45-degree field of view · 2346 by 1568 pixels
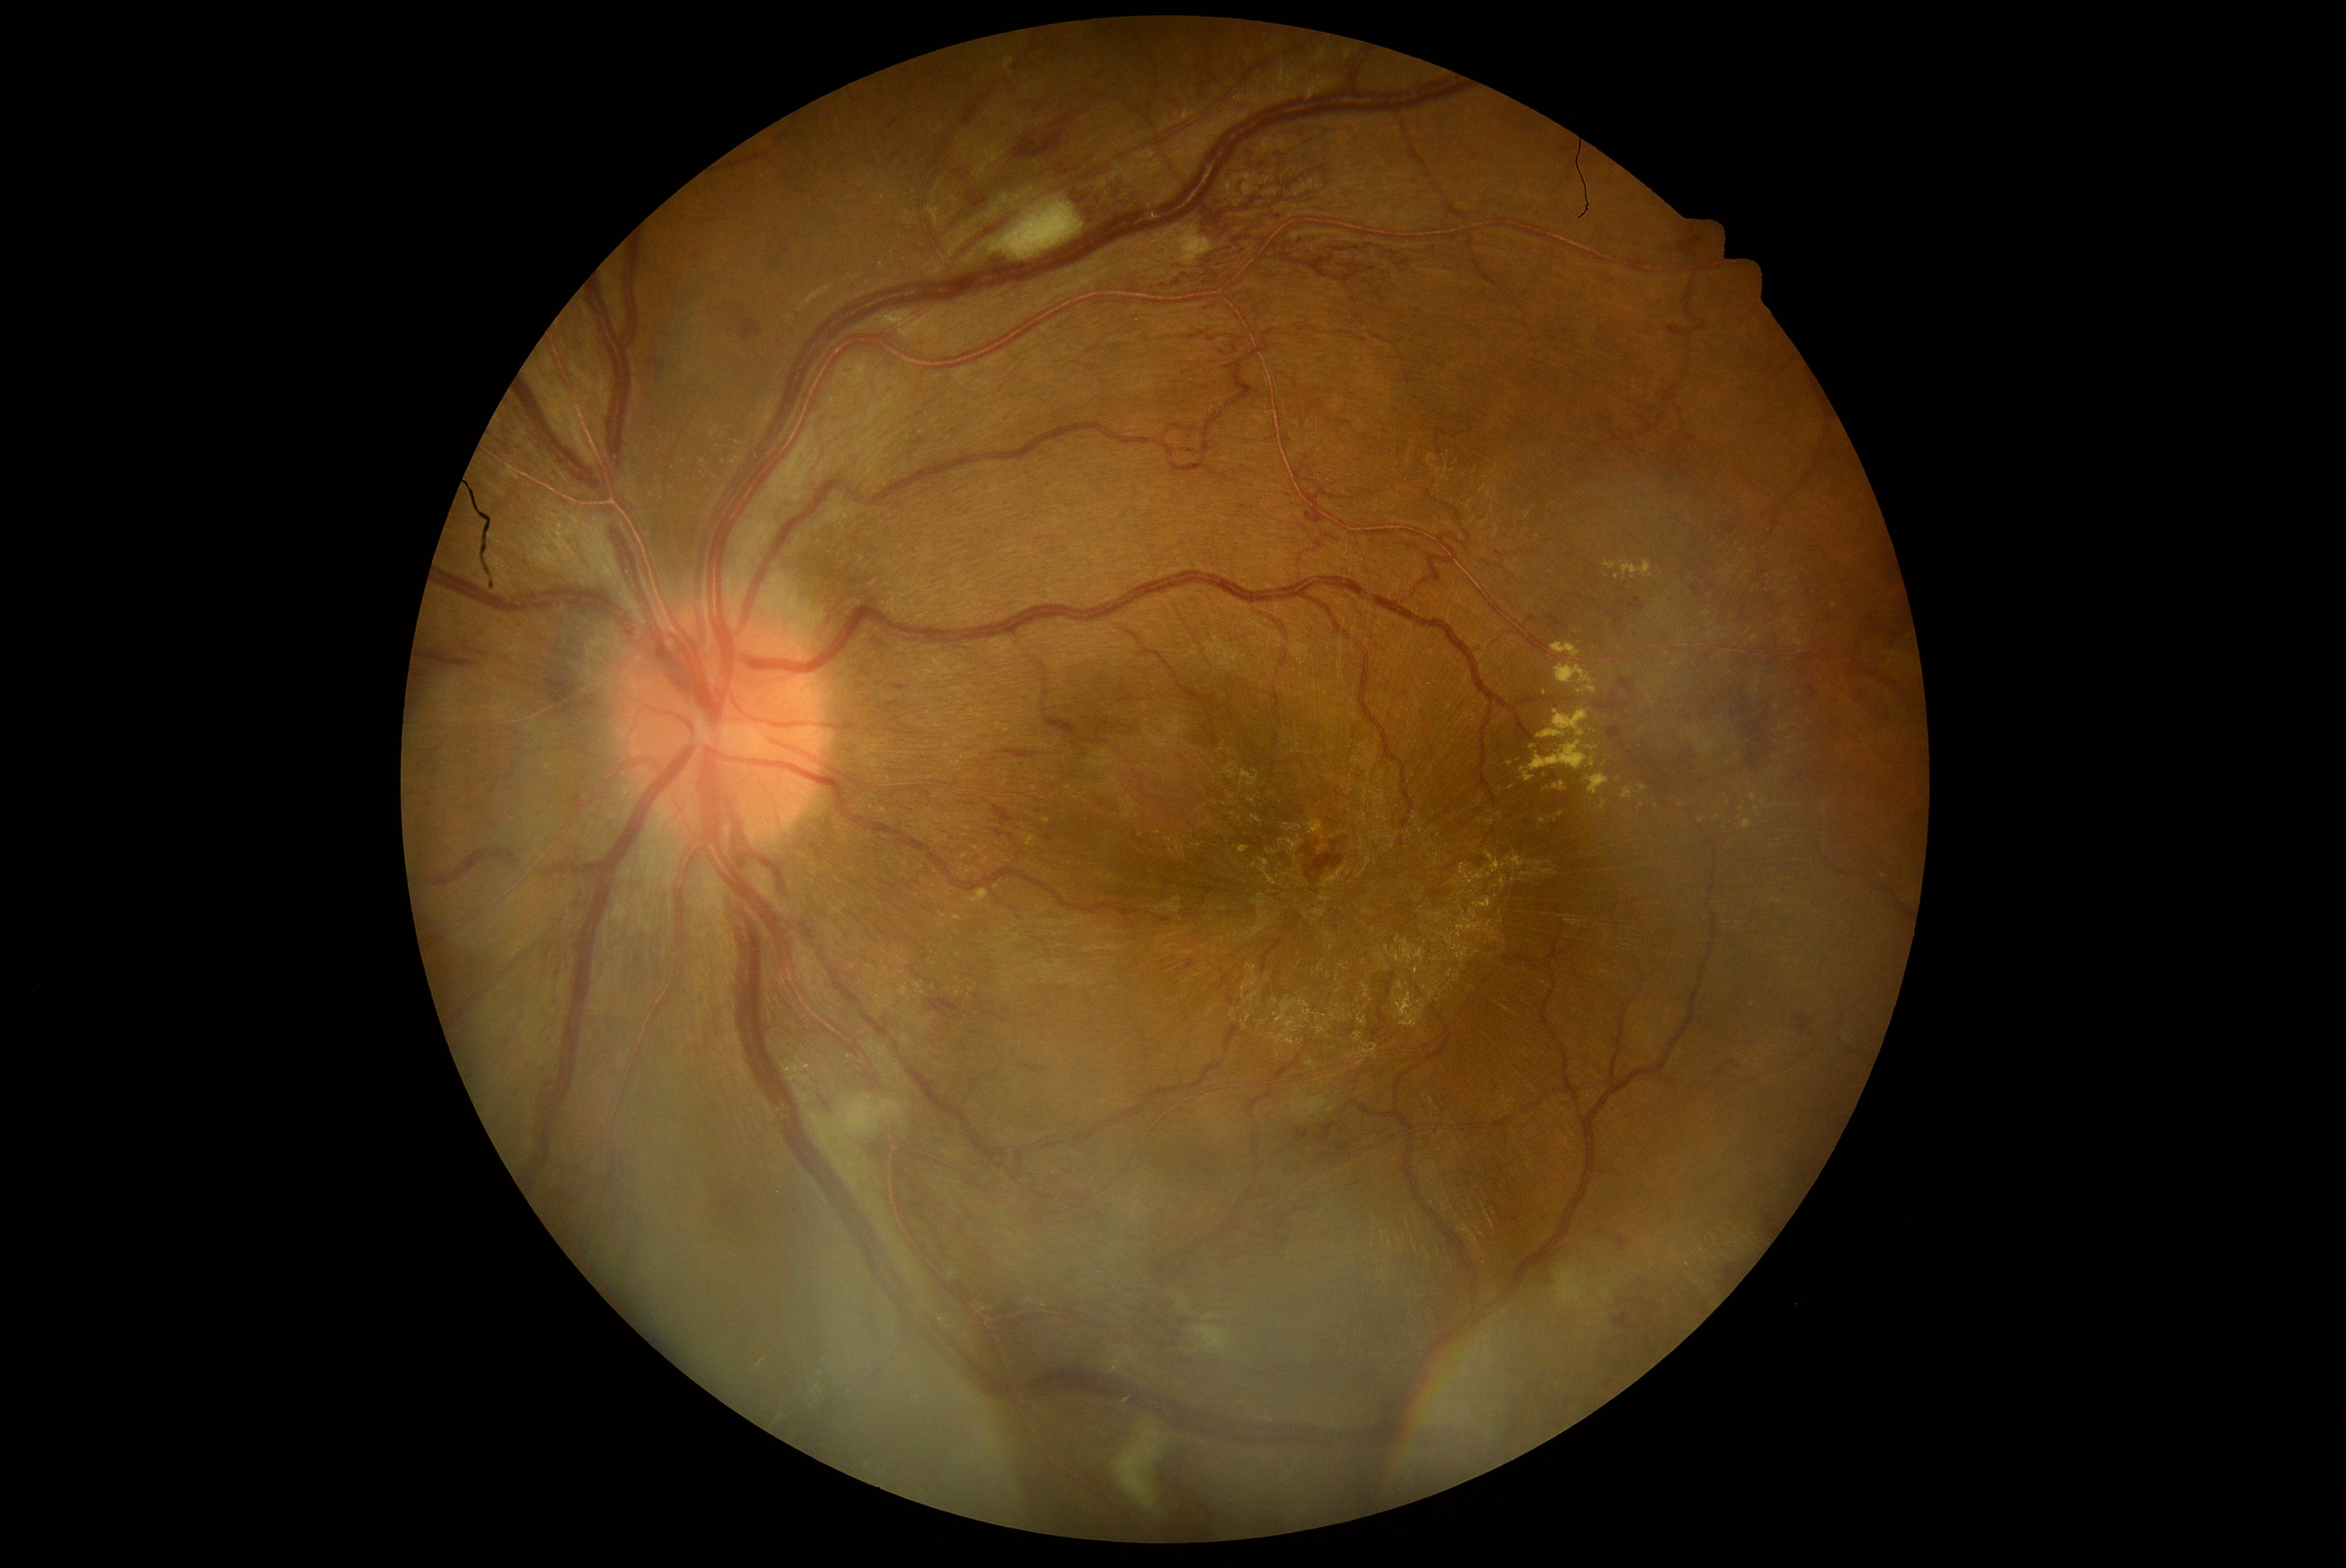

<lesions partial="true">
  <dr_grade>3</dr_grade>
  <he partial="true">Rect(1073, 169, 1174, 228) | Rect(567, 891, 589, 916) | Rect(1323, 1152, 1332, 1161) | Rect(1629, 750, 1640, 764) | Rect(993, 805, 1015, 827) | Rect(424, 652, 493, 673) | Rect(1298, 1128, 1310, 1144) | Rect(1591, 1224, 1608, 1241) | Rect(1284, 1161, 1301, 1175) | Rect(1613, 1313, 1641, 1335) | Rect(1710, 583, 1718, 590) | Rect(1600, 1334, 1630, 1346) | Rect(1713, 1056, 1743, 1083) | Rect(1624, 697, 1635, 708)</he>
  <he_small>(1006,180) | (1358,1183) | (1674,767) | (1683,762) | (1830,618) | (1101,75)</he_small>
</lesions>